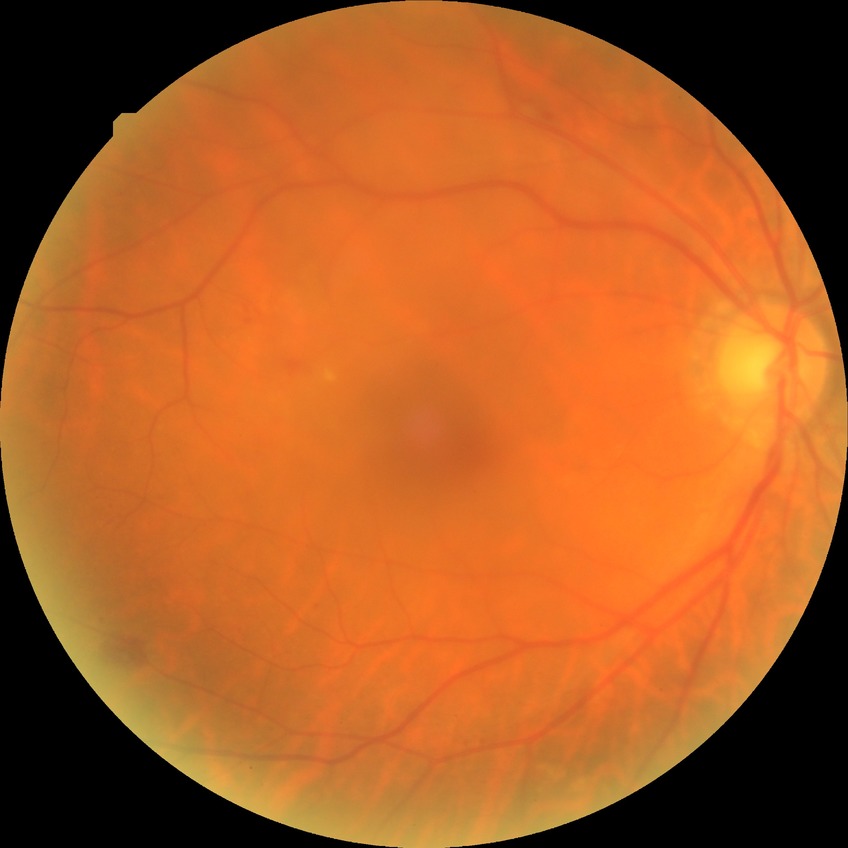

Diabetic retinopathy (DR) is no diabetic retinopathy (NDR).